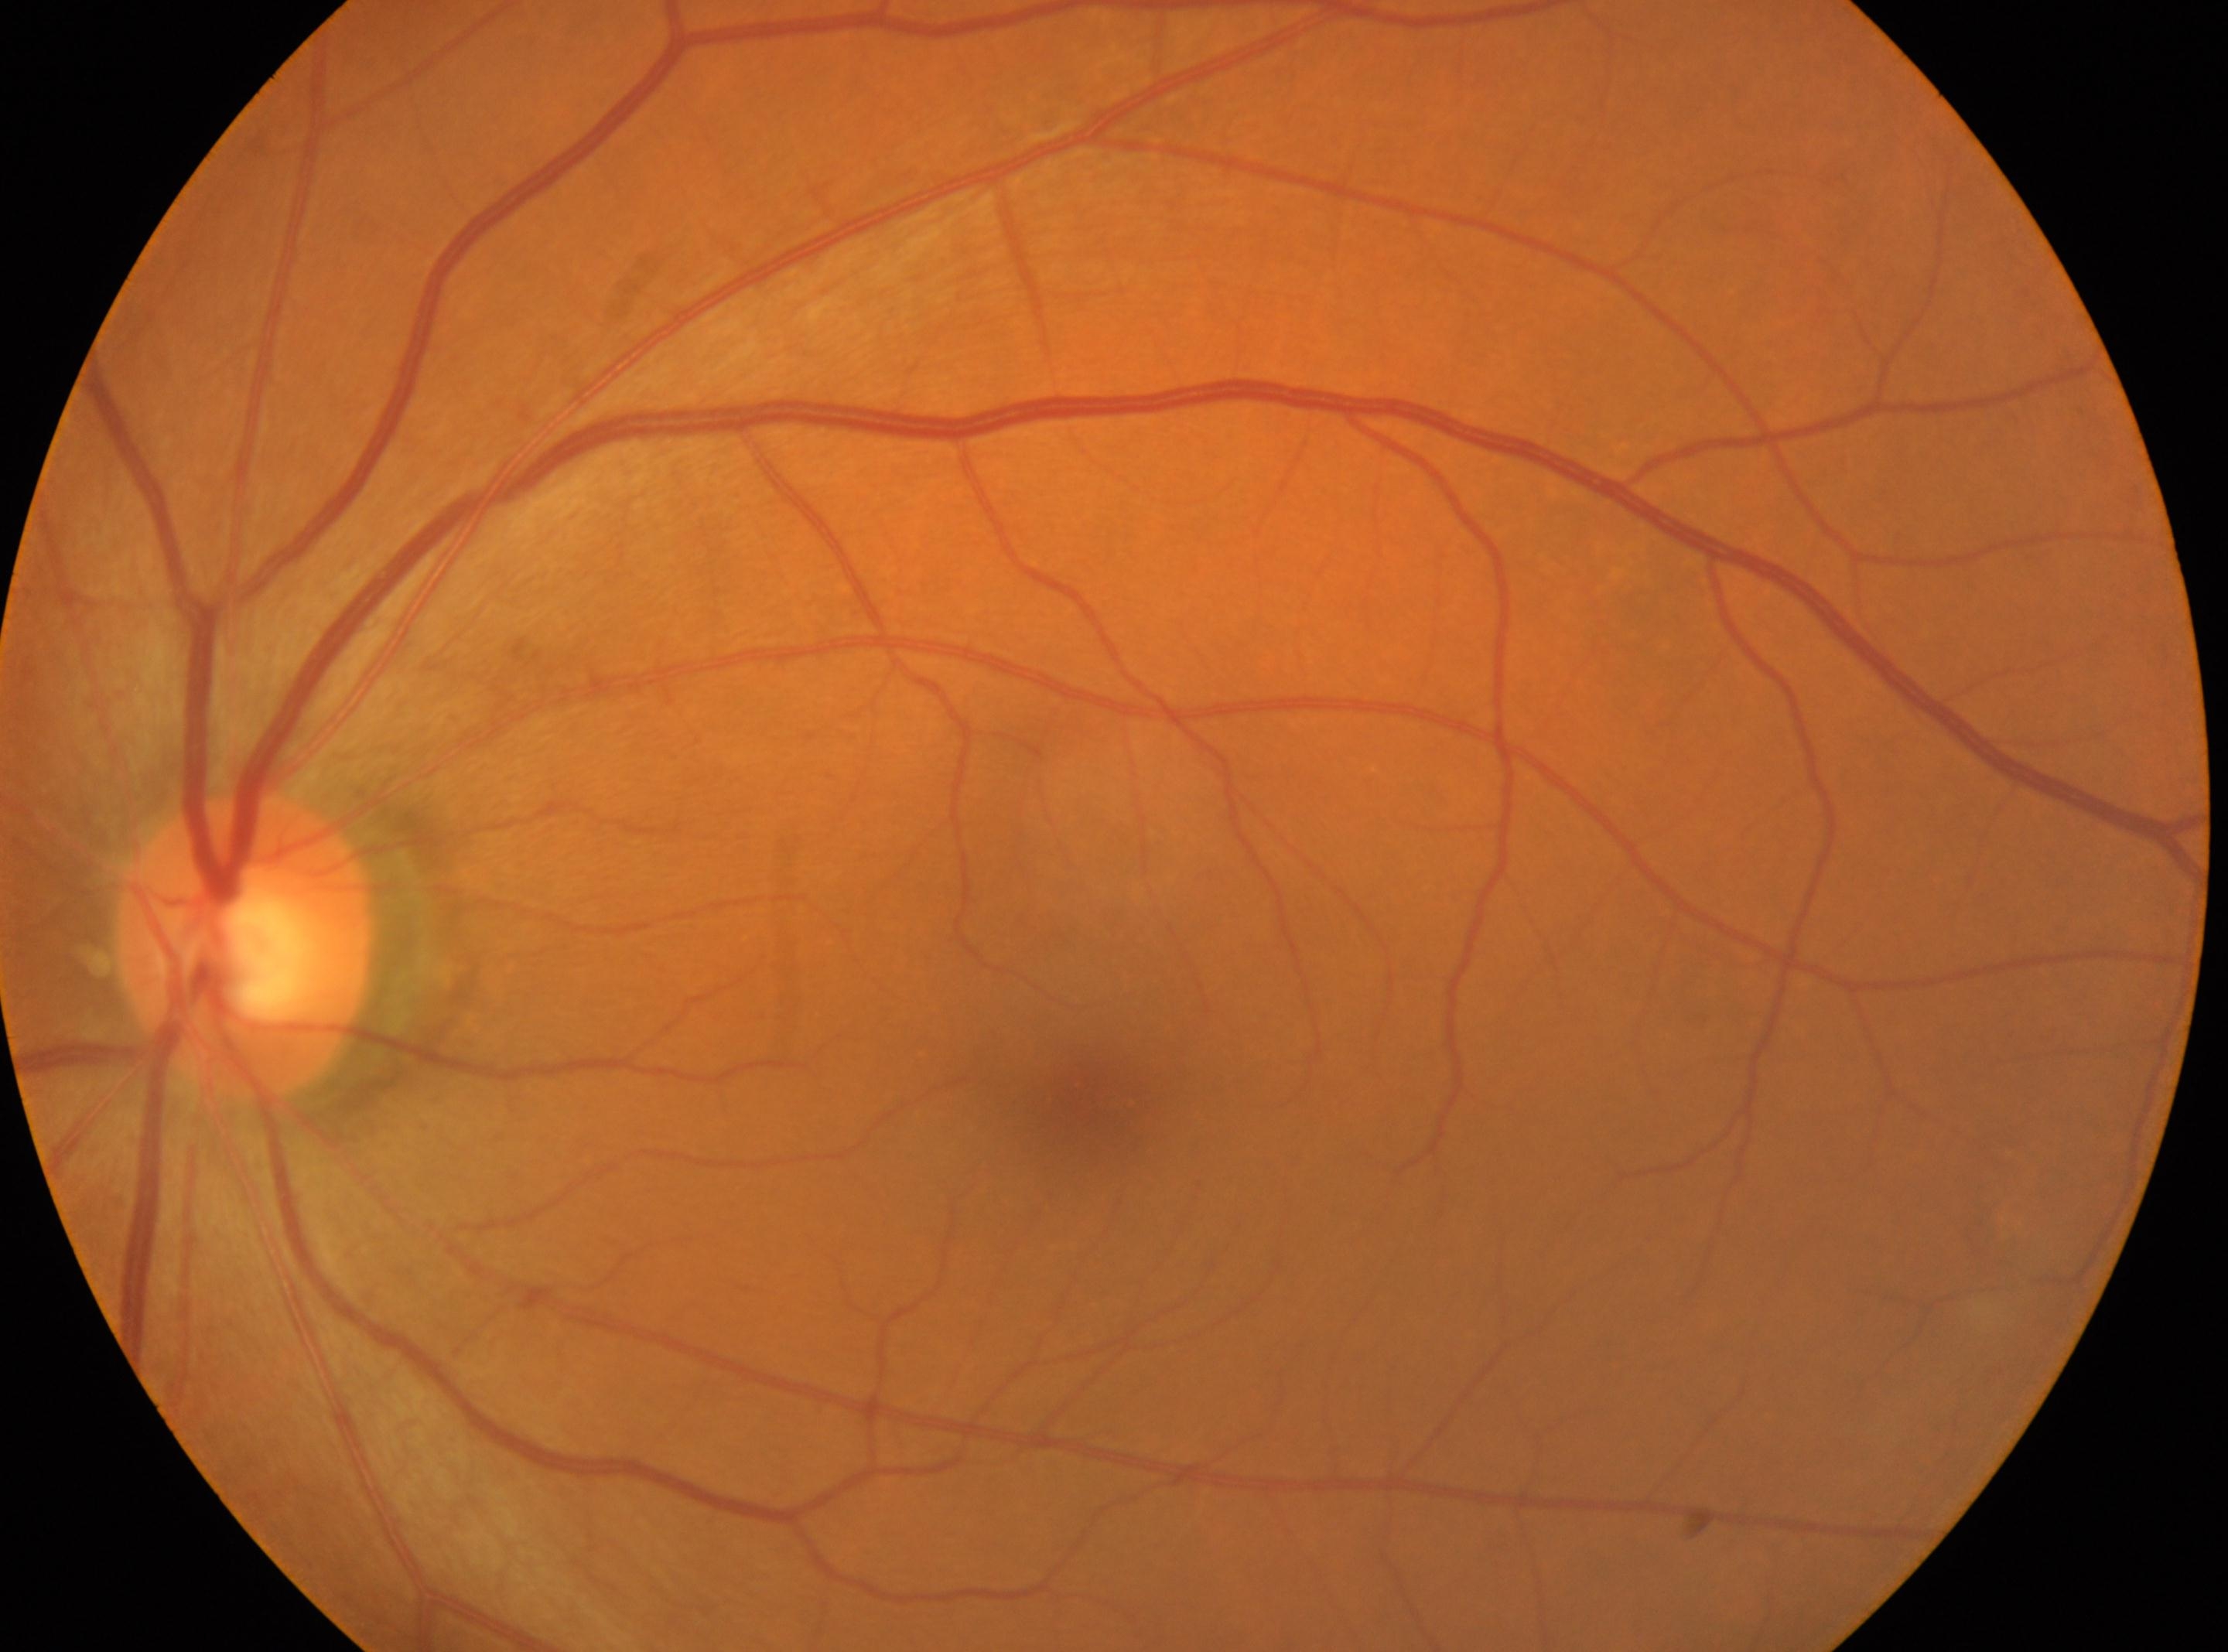
DR=0
disc center=(244, 945)
the fovea=(1103, 1095)
the left eye